Acquired with a NIDEK AFC-230 · without pupil dilation · 848x848px · color fundus image.
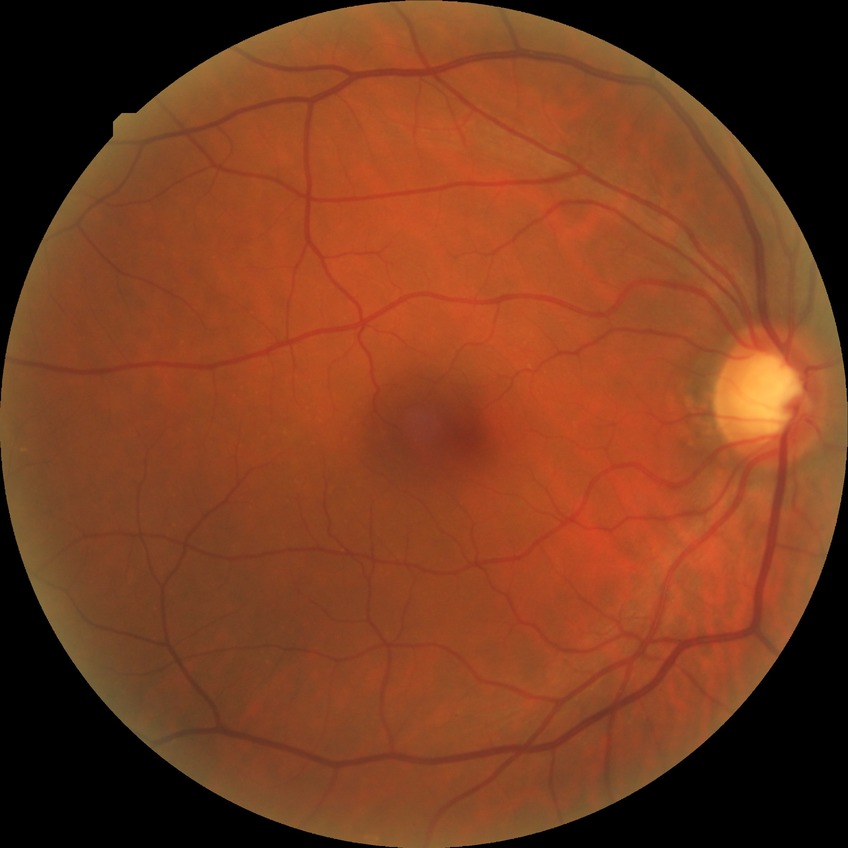 Retinopathy grade: no diabetic retinopathy.